50° field of view · CFP:
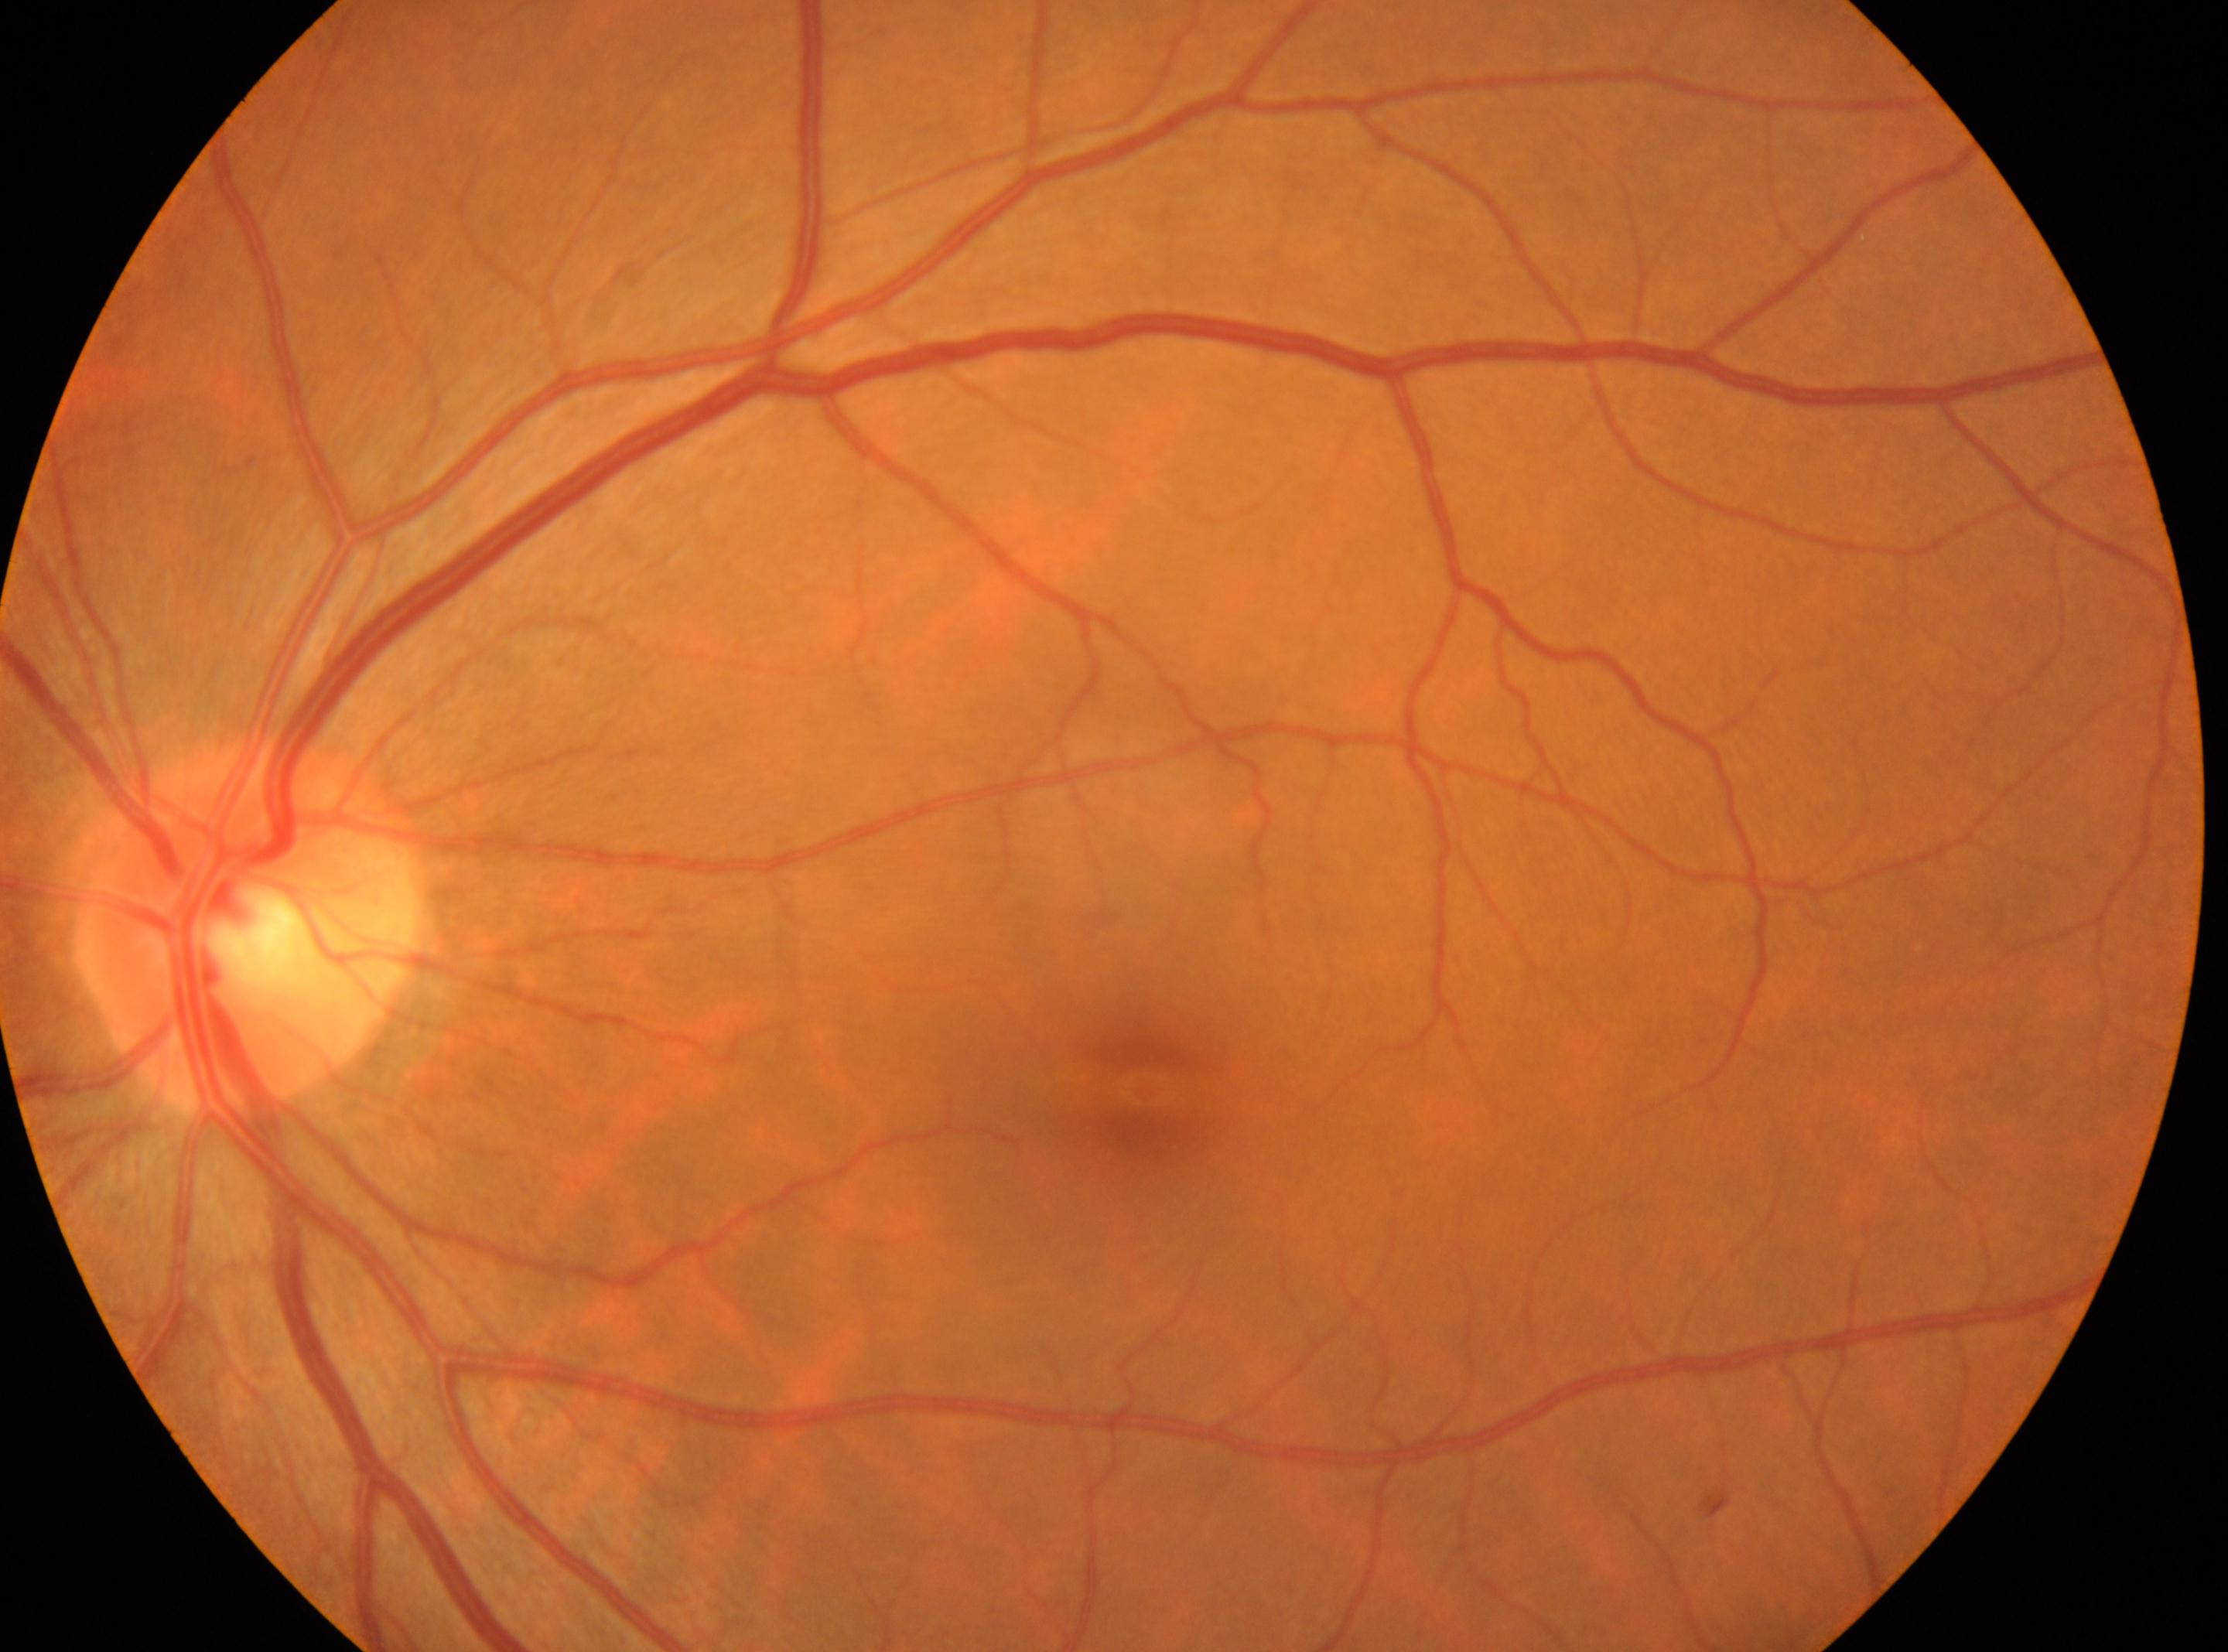
DR is no apparent retinopathy (grade 0).
Fovea: (1143, 1086).
Optic disc center: (252, 928).
Eye: OS.